Retinal fundus photograph; 45-degree field of view:
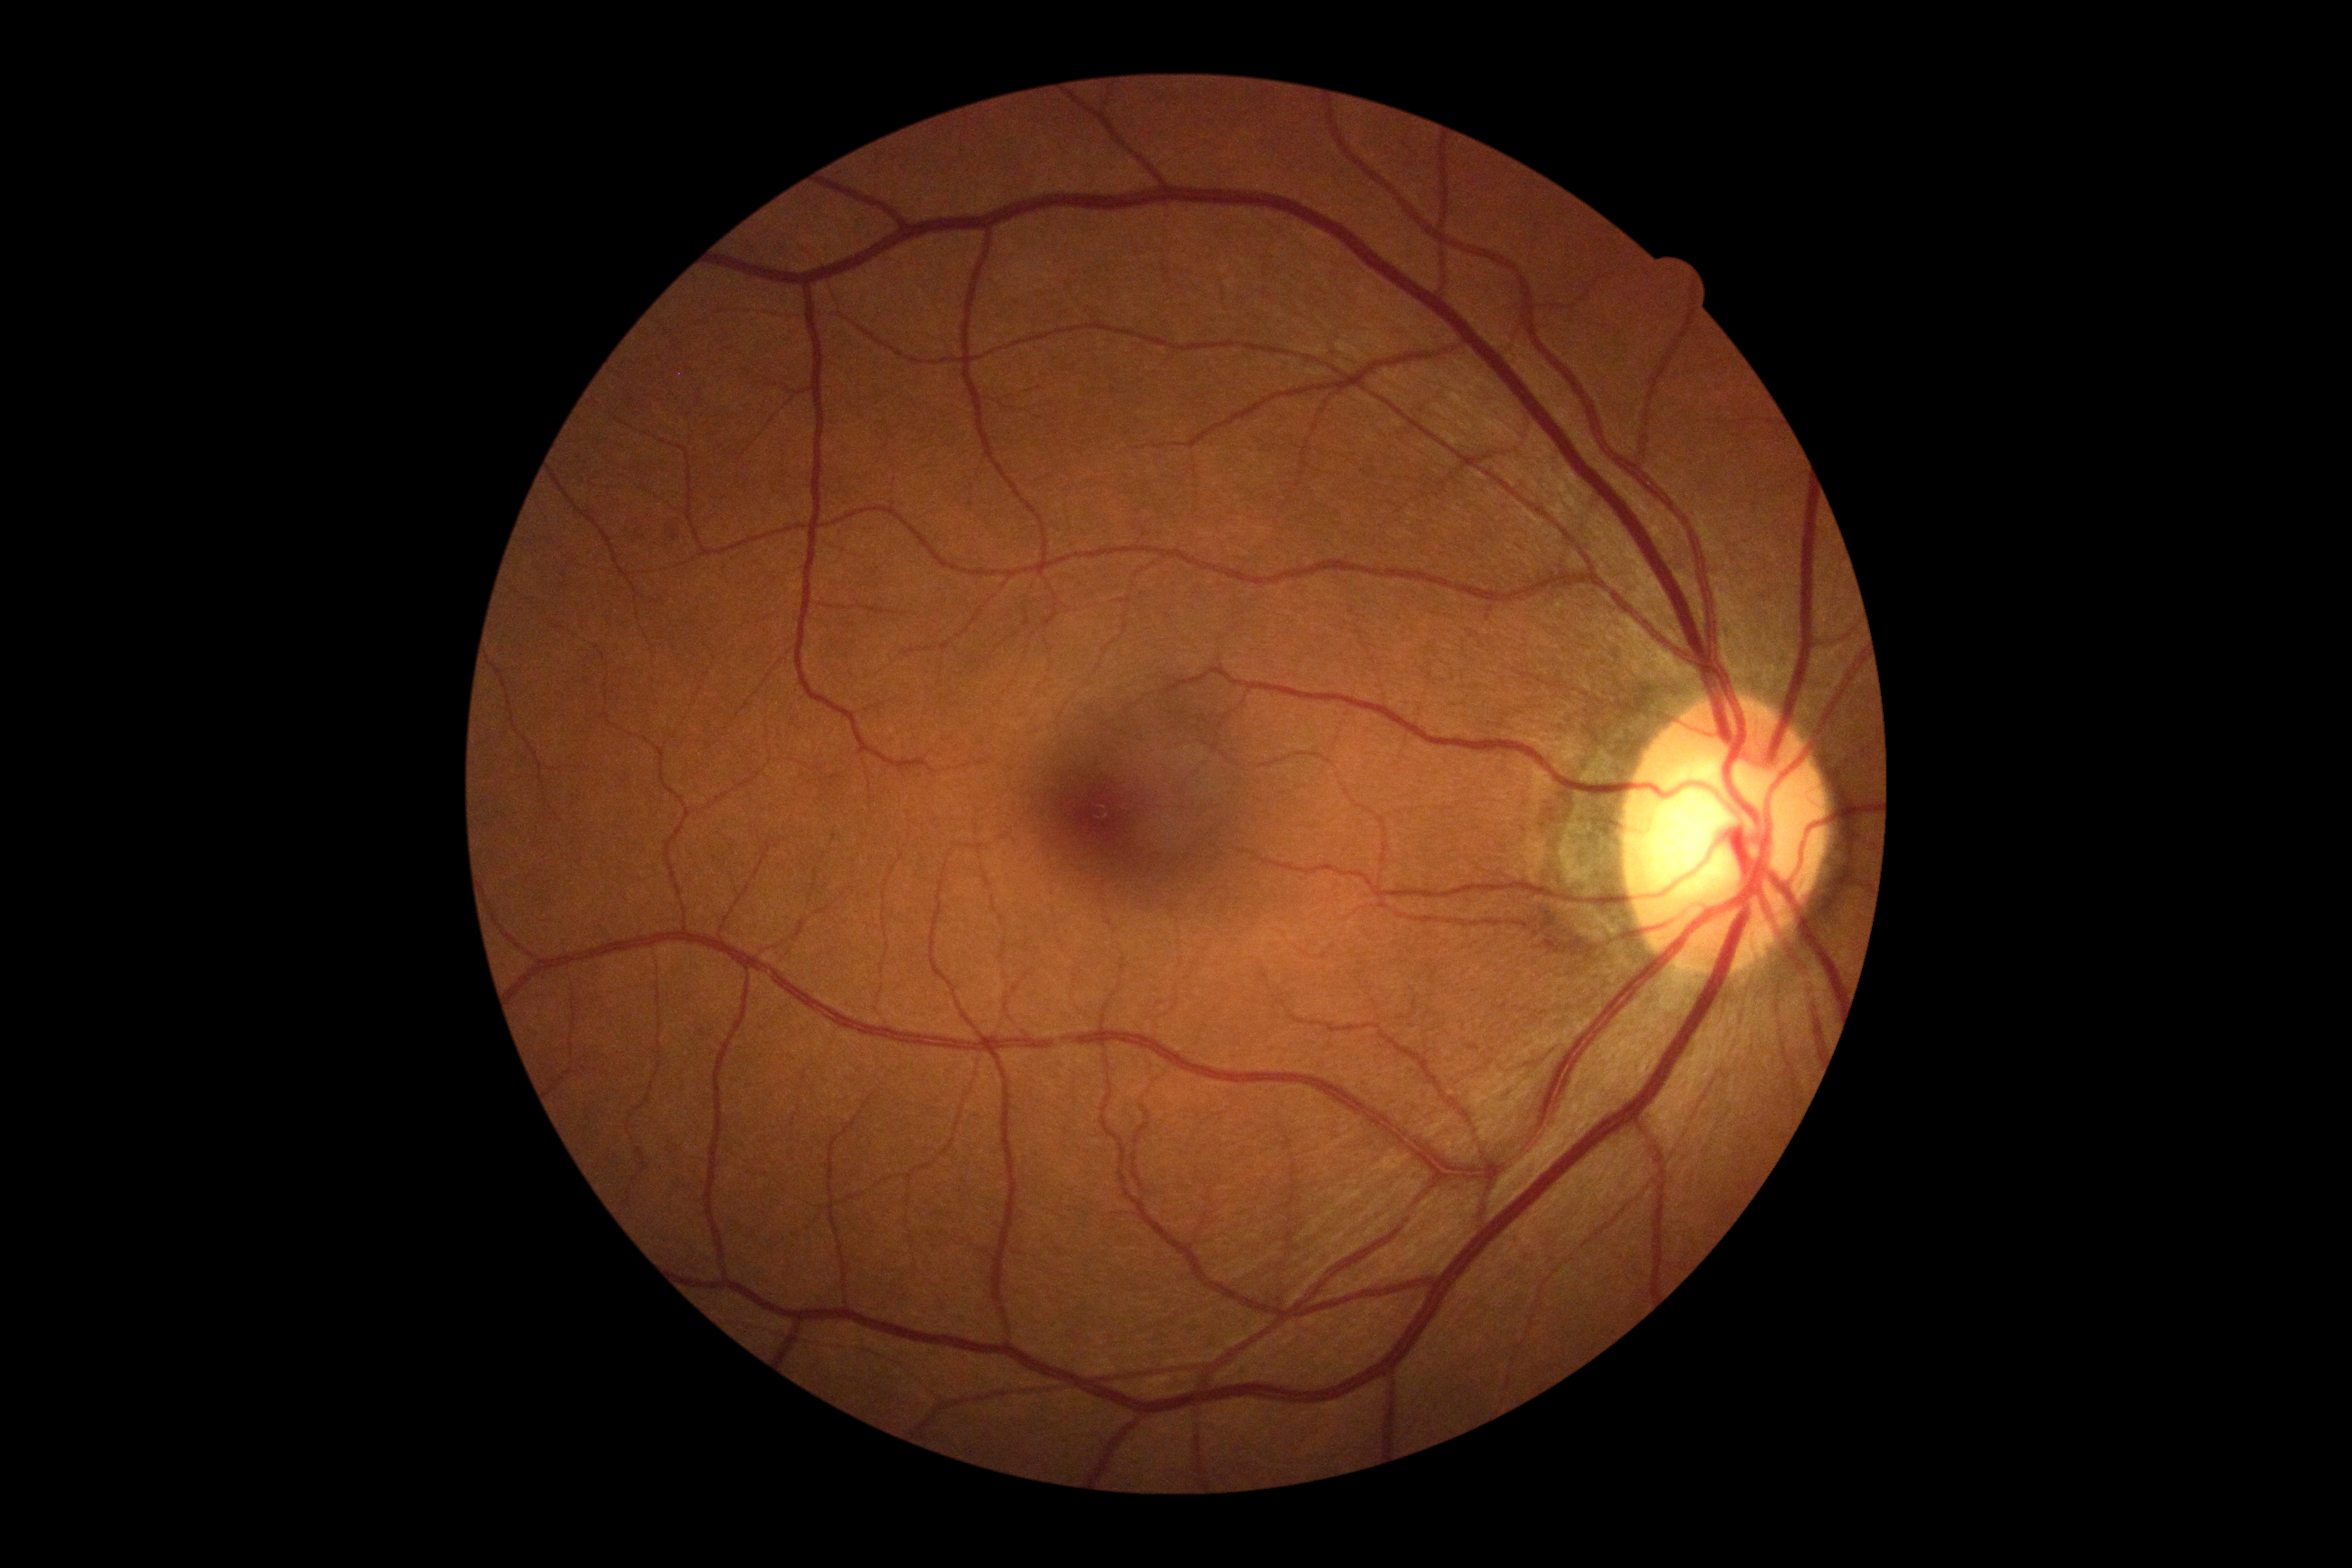 No apparent diabetic retinopathy.
Retinopathy is no apparent retinopathy (grade 0).